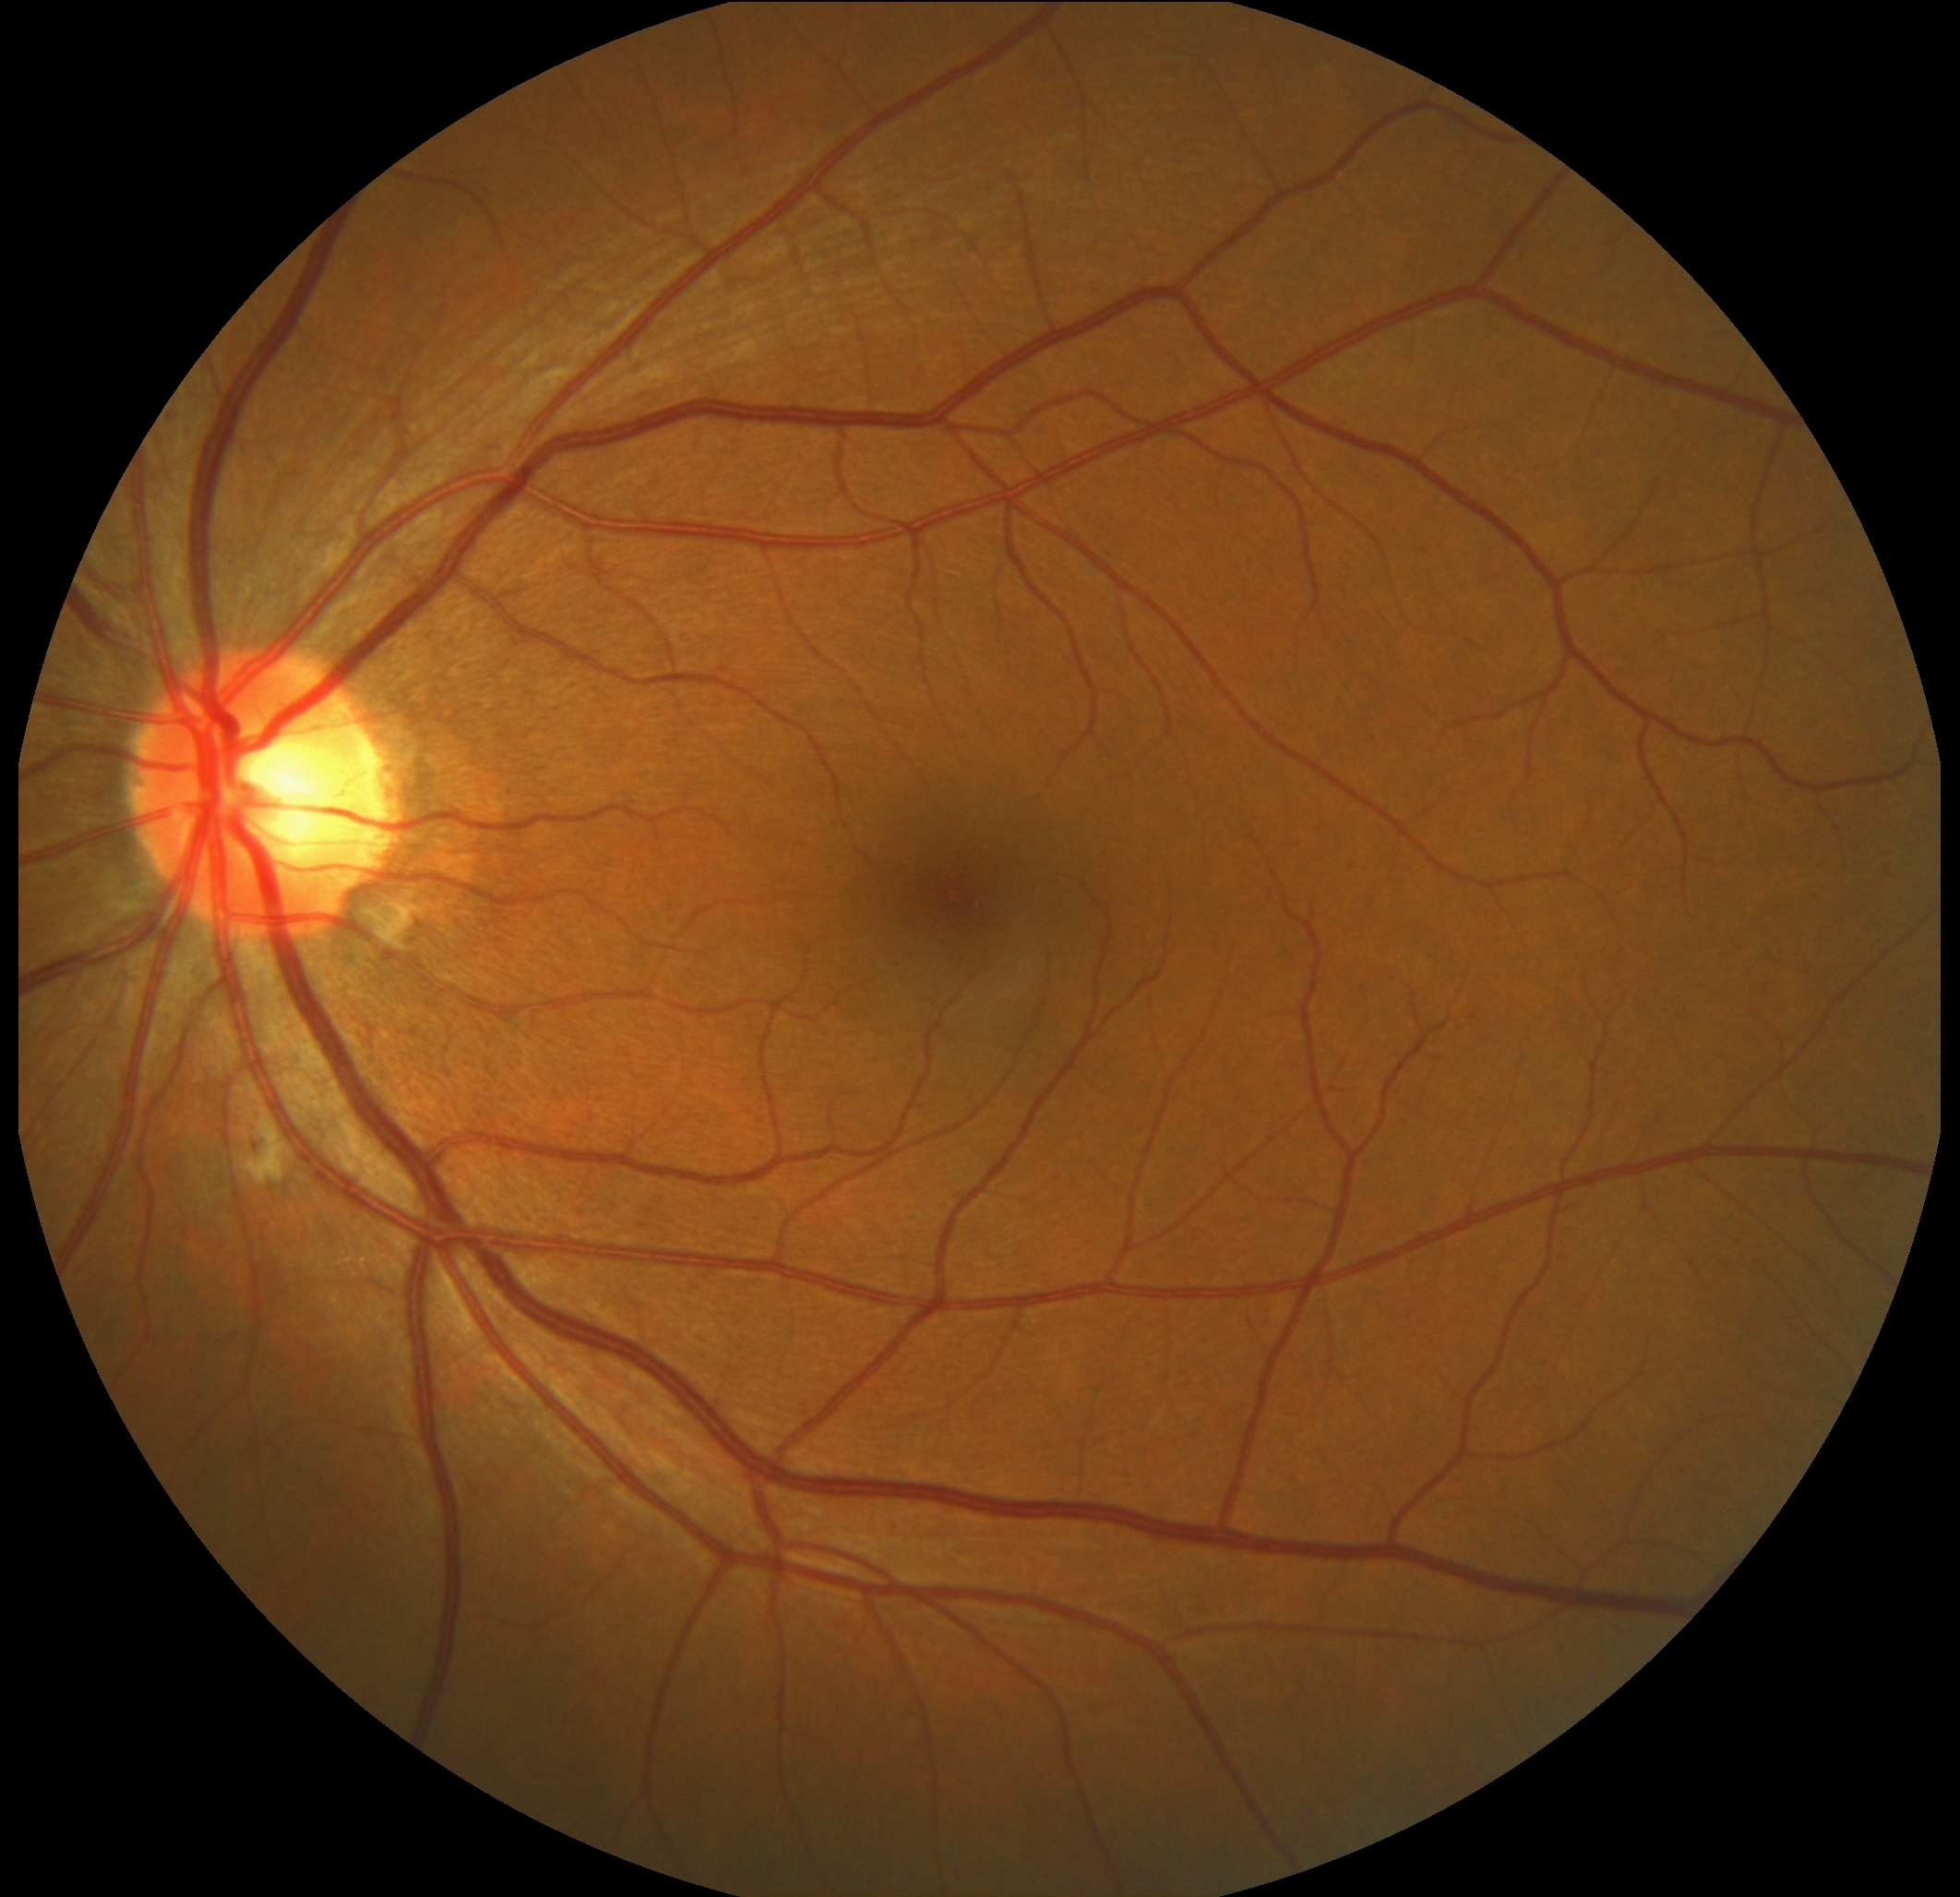
DR: moderate non-proliferative diabetic retinopathy (grade 2).